Color fundus photograph, 2212x1659px: 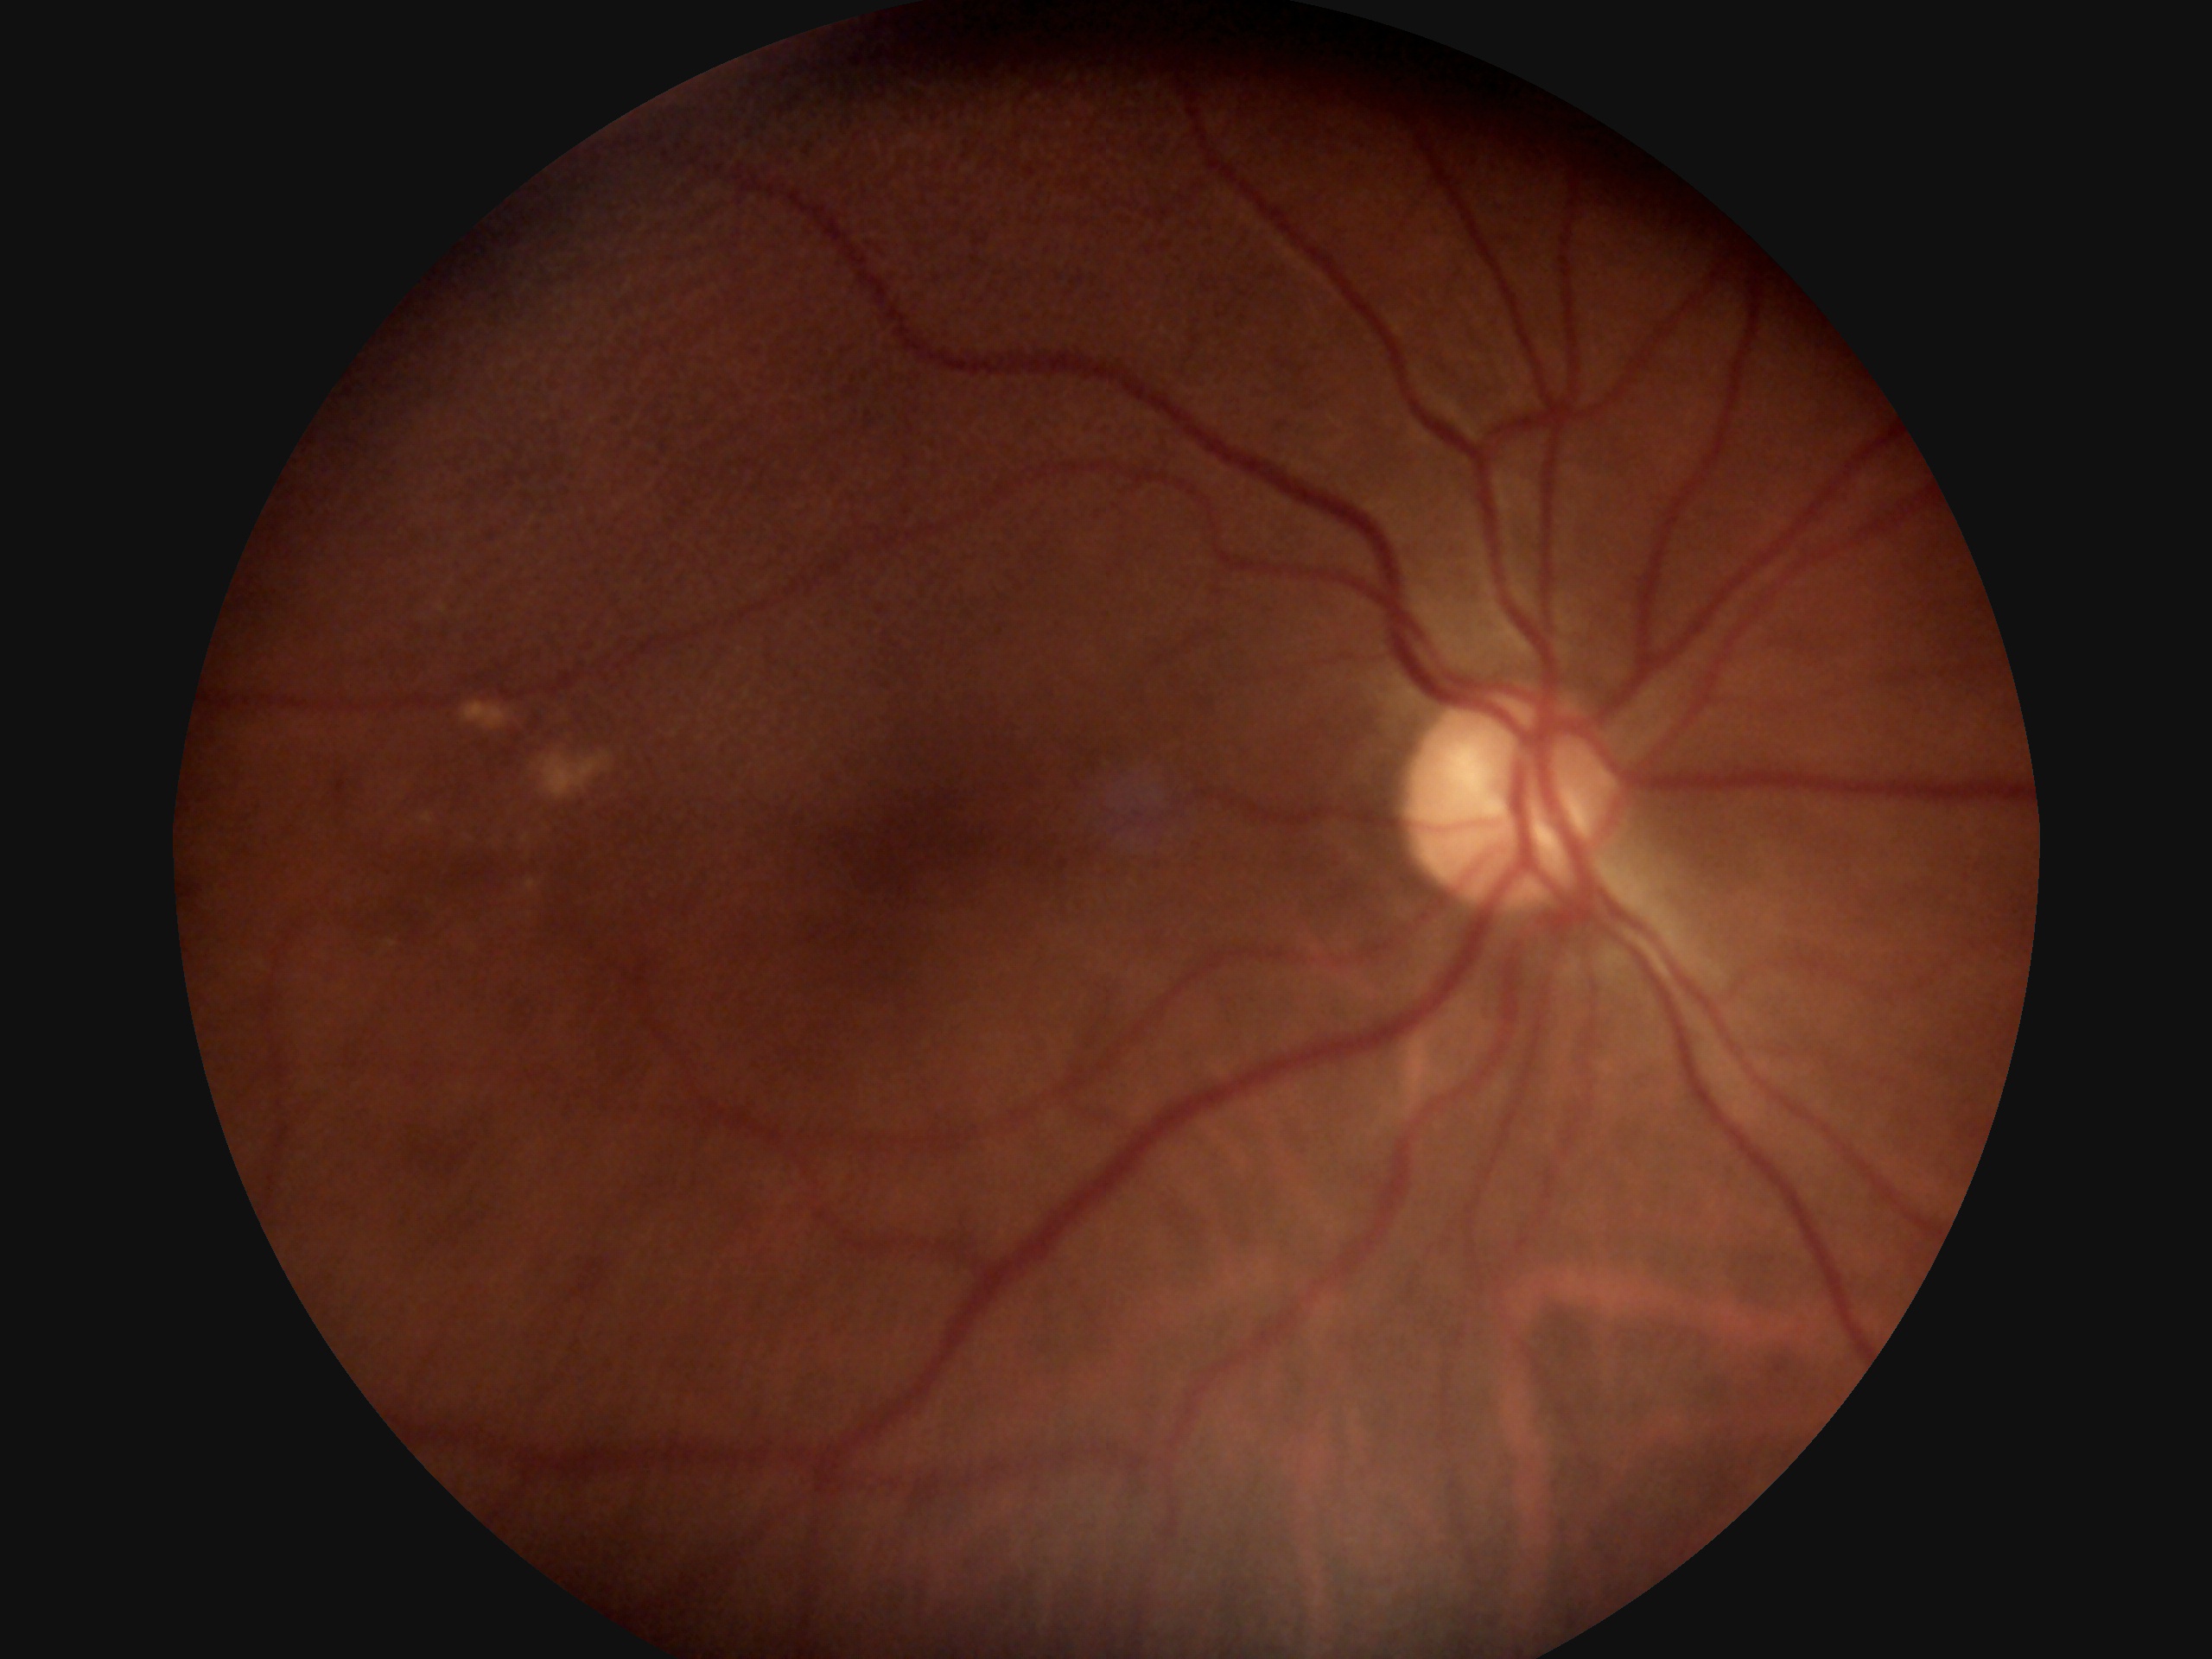

Diabetic retinopathy: 2/4.